Non-mydriatic acquisition.
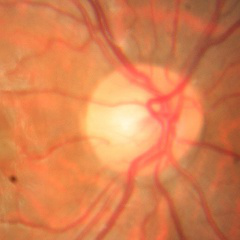 Optic disc appearance consistent with no glaucomatous optic neuropathy.